Remidio FOP fundus camera, retinal fundus photograph:
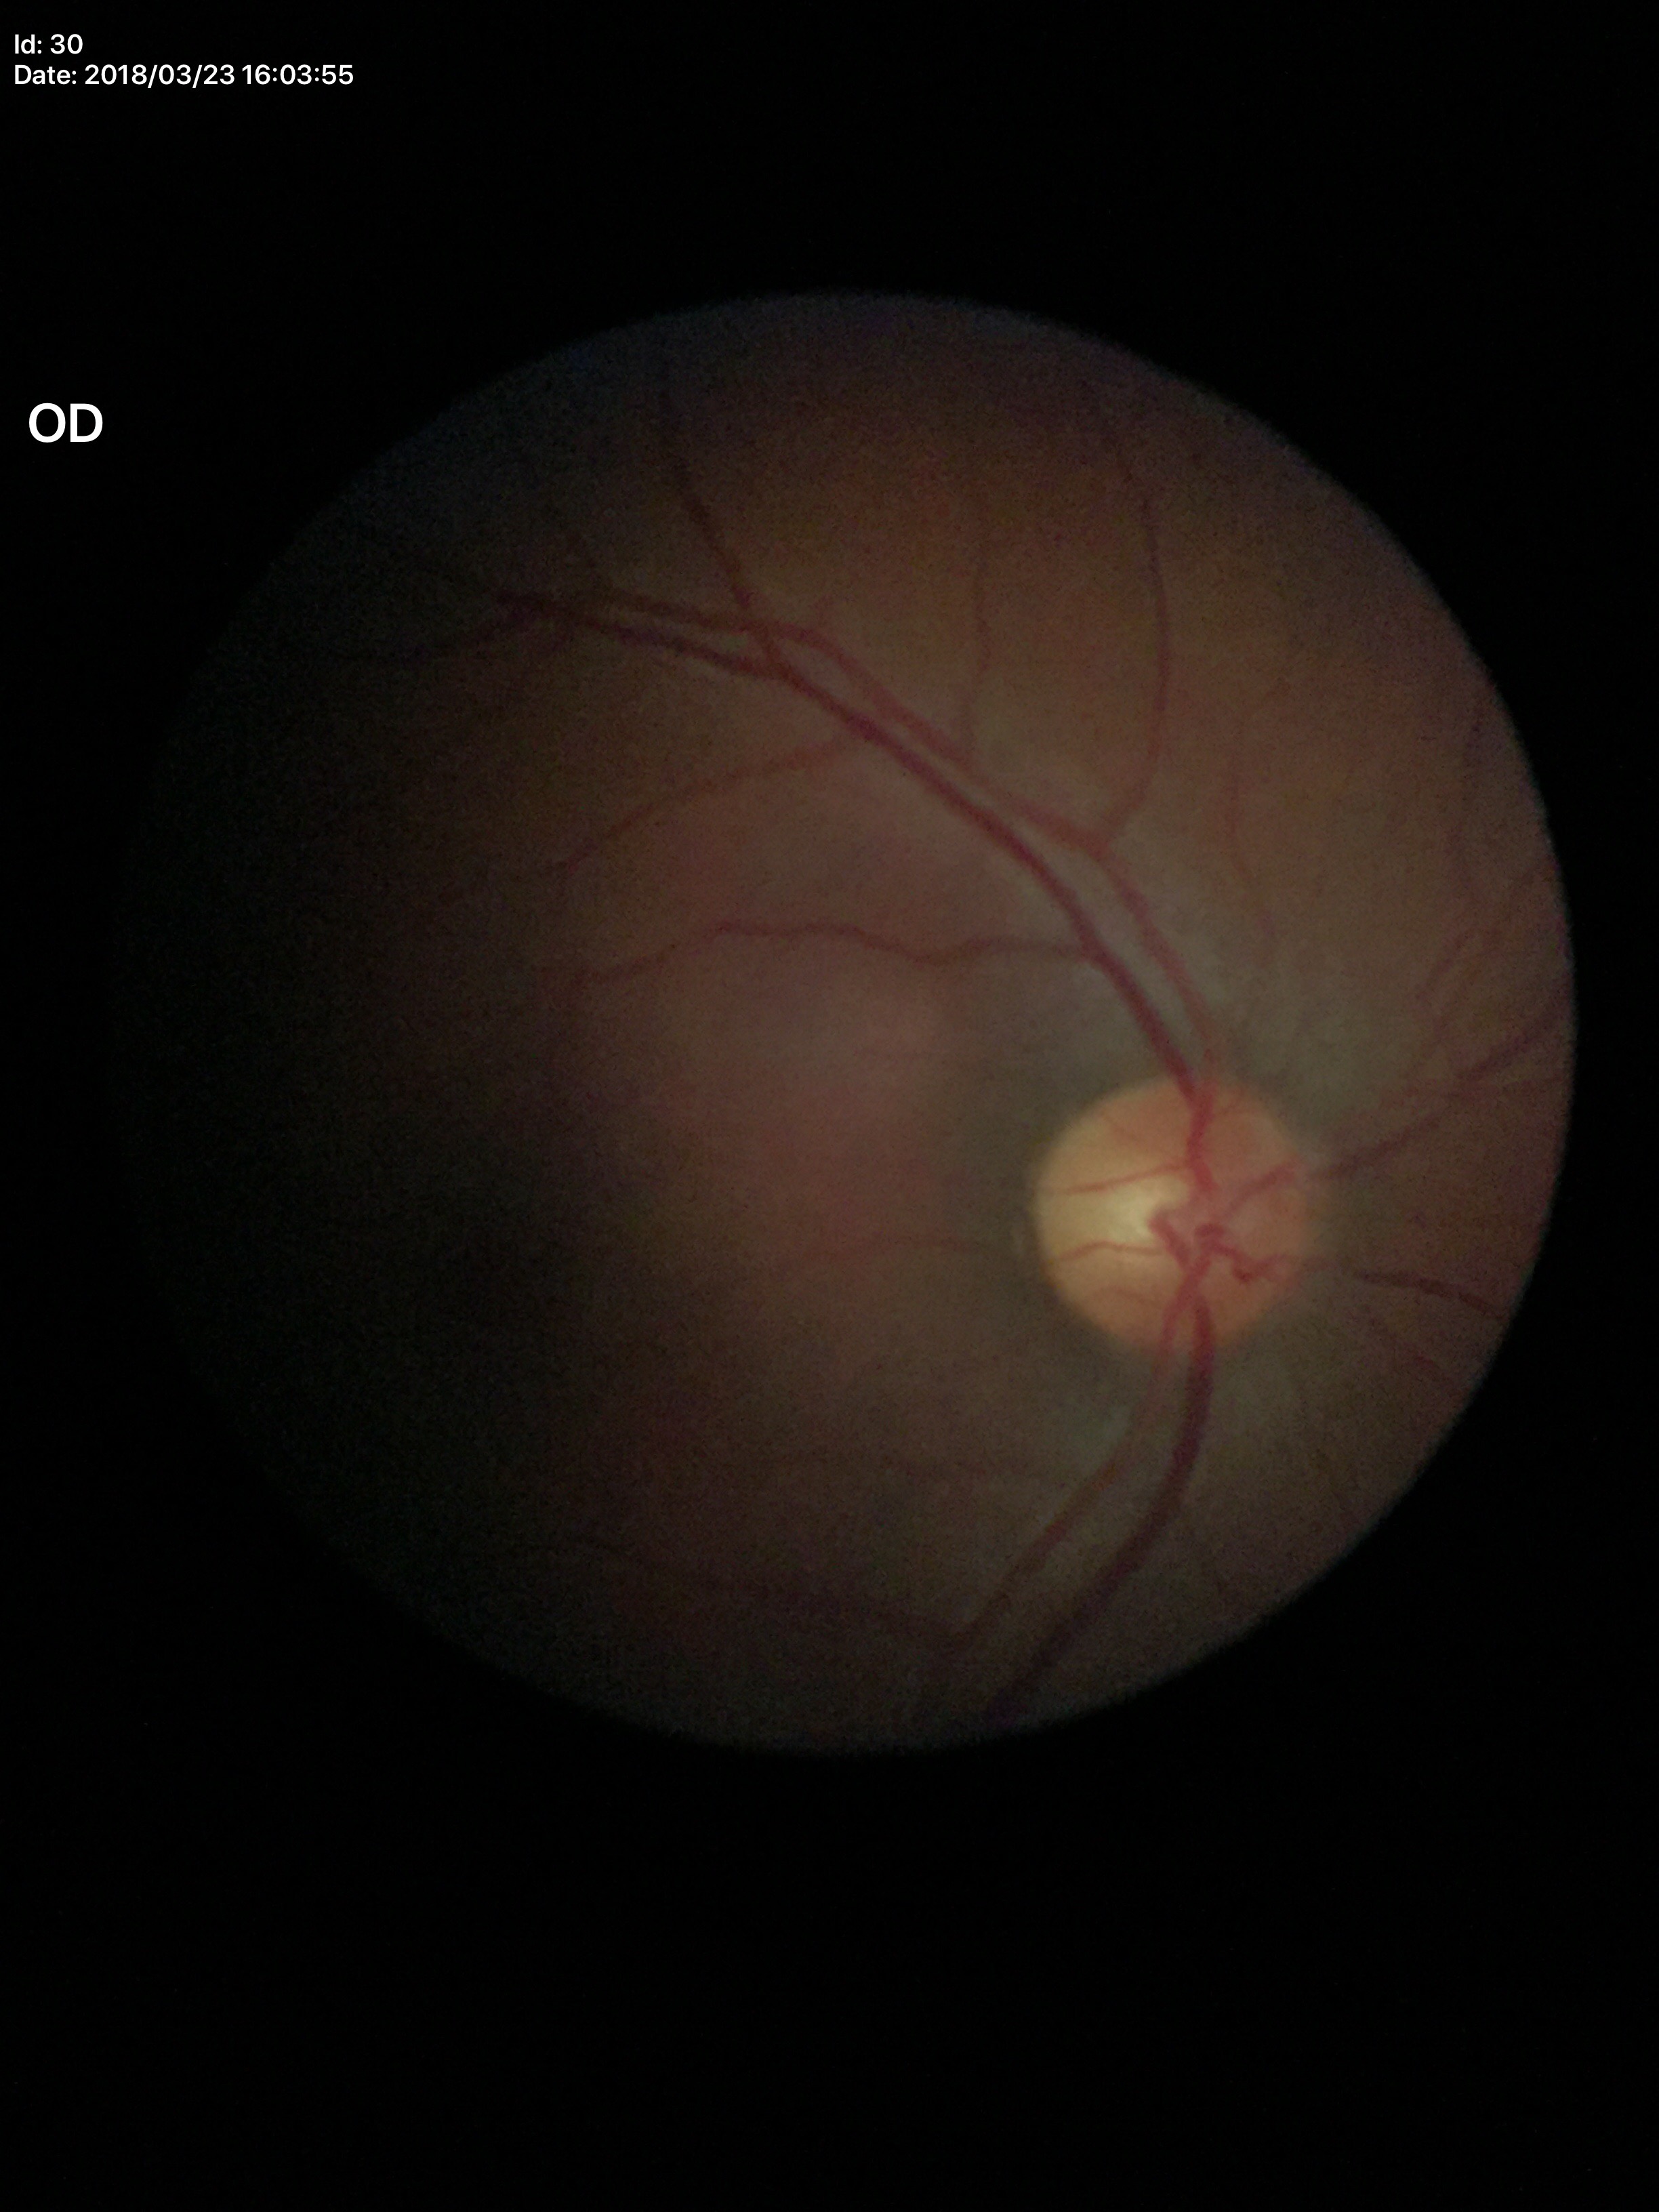
Glaucoma assessment = not suspect
vertical CDR = 0.45